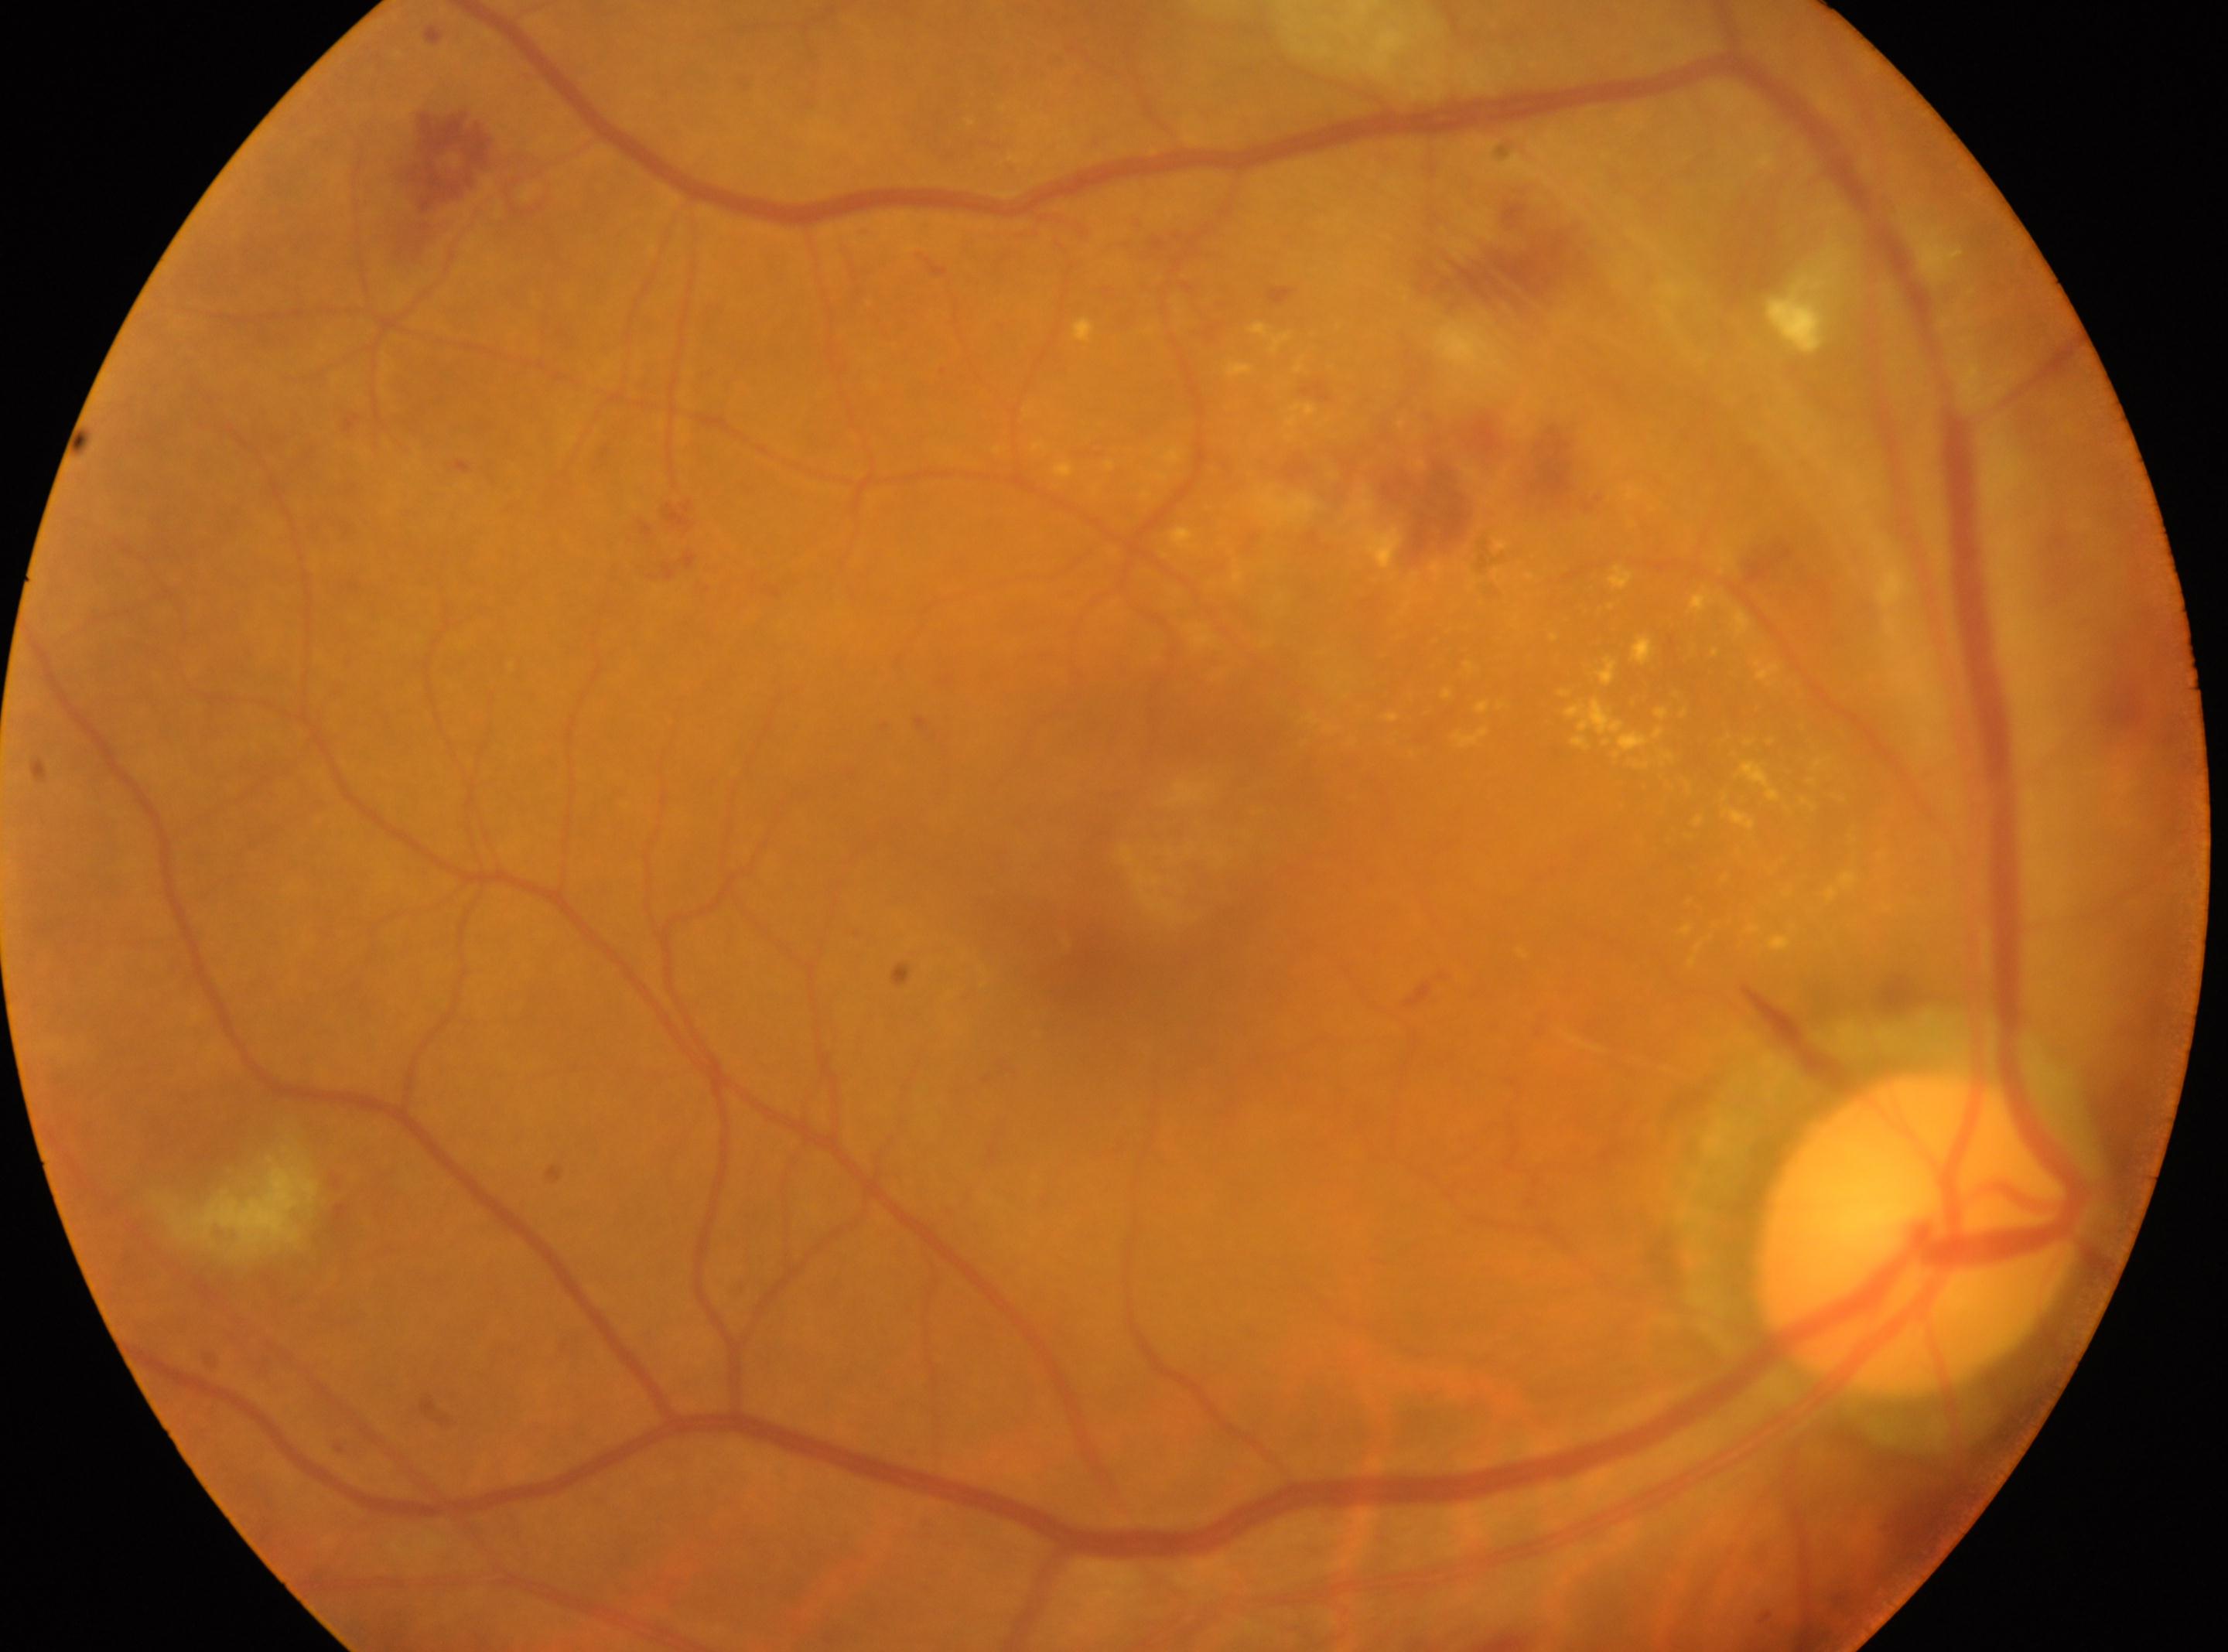
| key | value |
|---|---|
| foveal center | 1072, 959 |
| laterality | oculus dexter |
| diabetic retinopathy grade | 2/4 |
| disc center | 1919, 1233 |